Wide-field fundus photograph from neonatal ROP screening. 1240x1240:
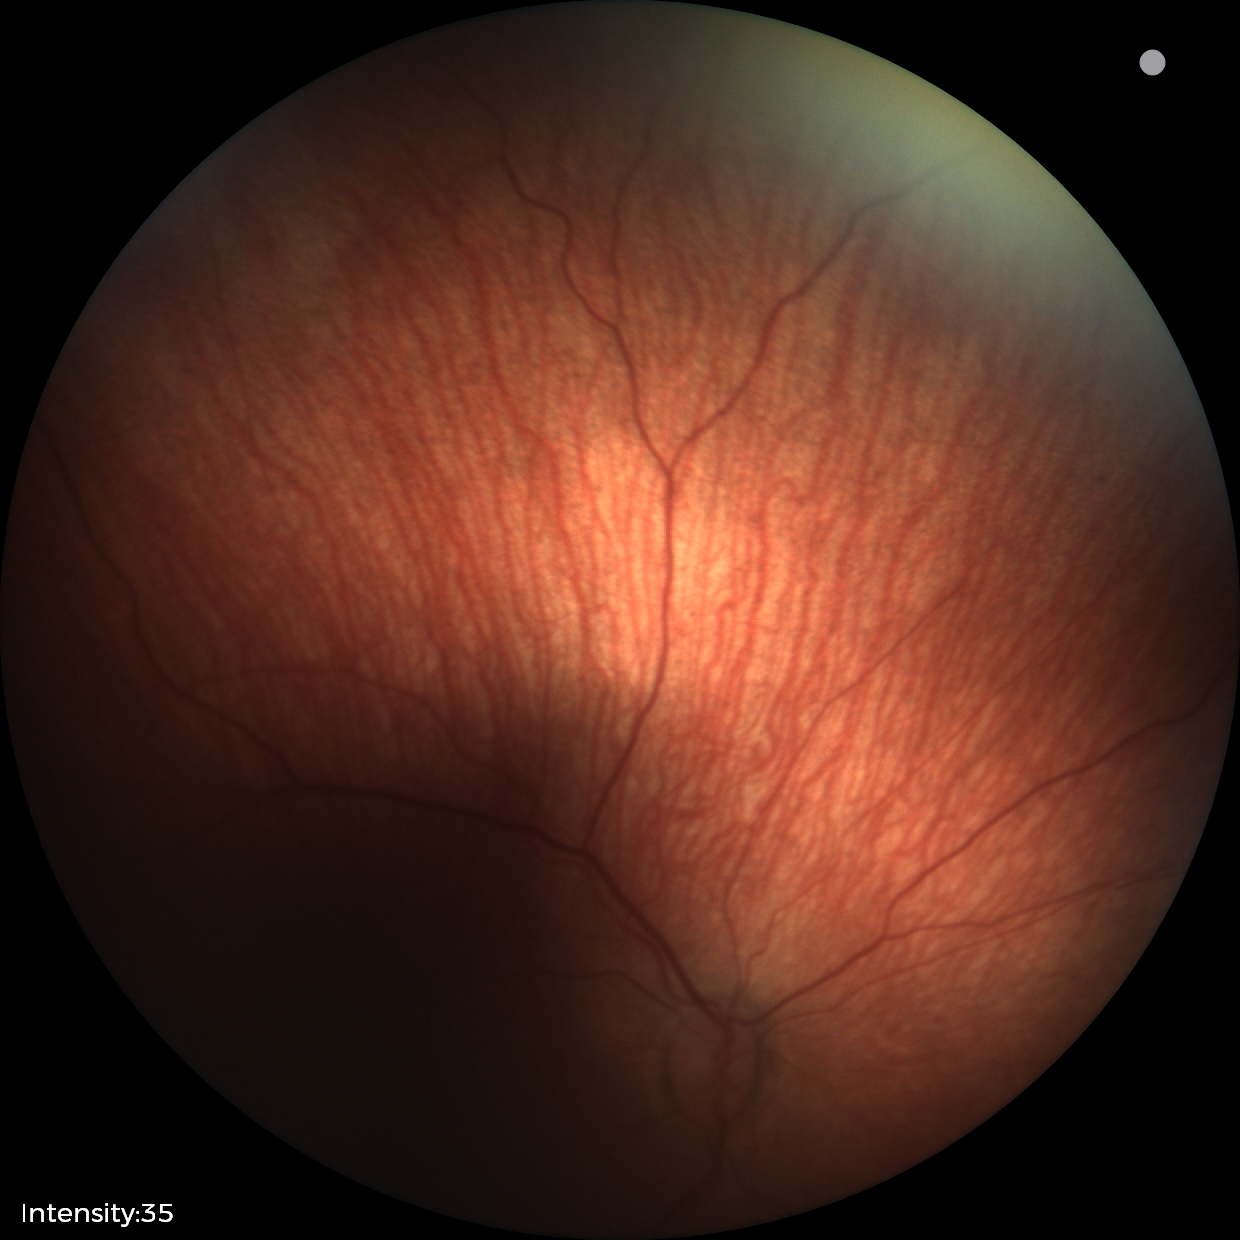
Plus disease absent.
Screening examination consistent with status post ROP.